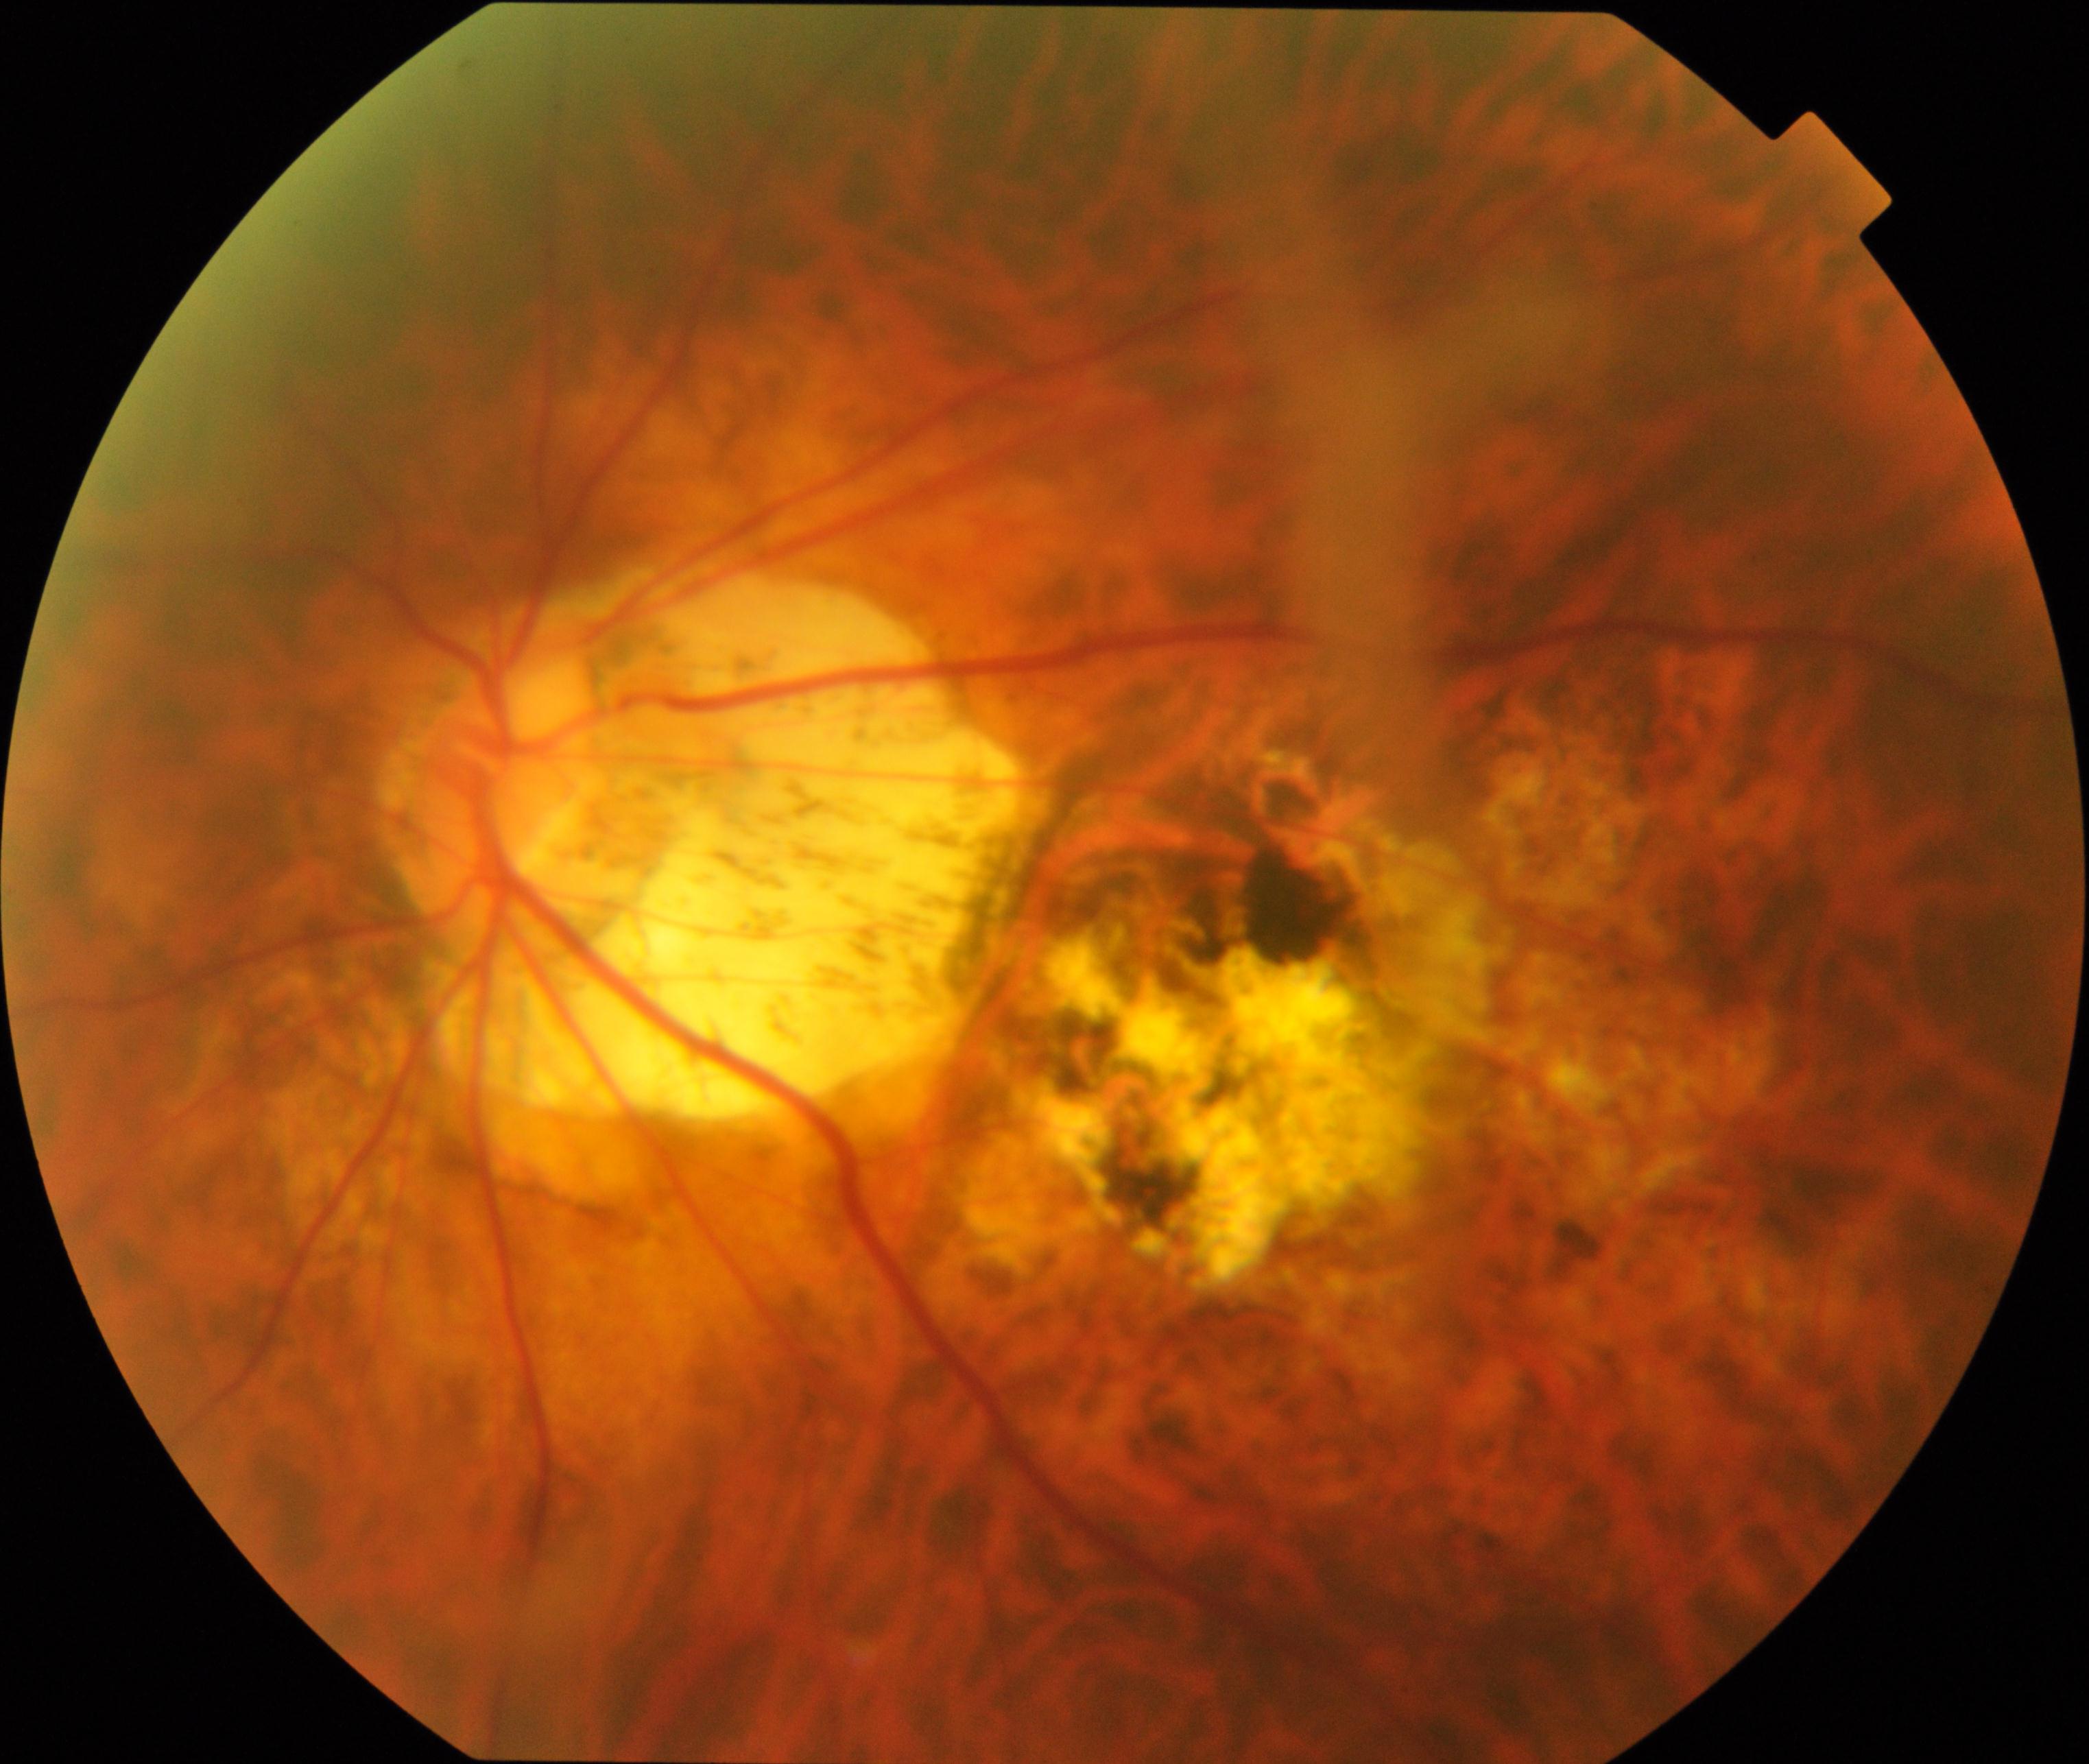 The image shows pathological myopia.